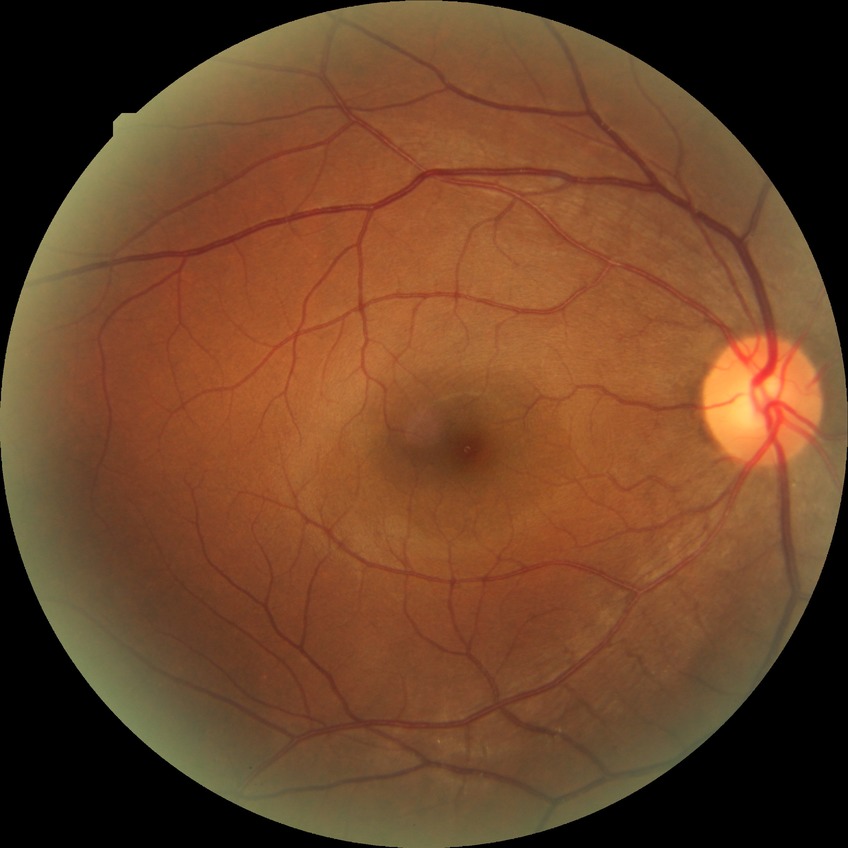 Davis grading is no diabetic retinopathy.